2089x1764. Retinal fundus photograph.
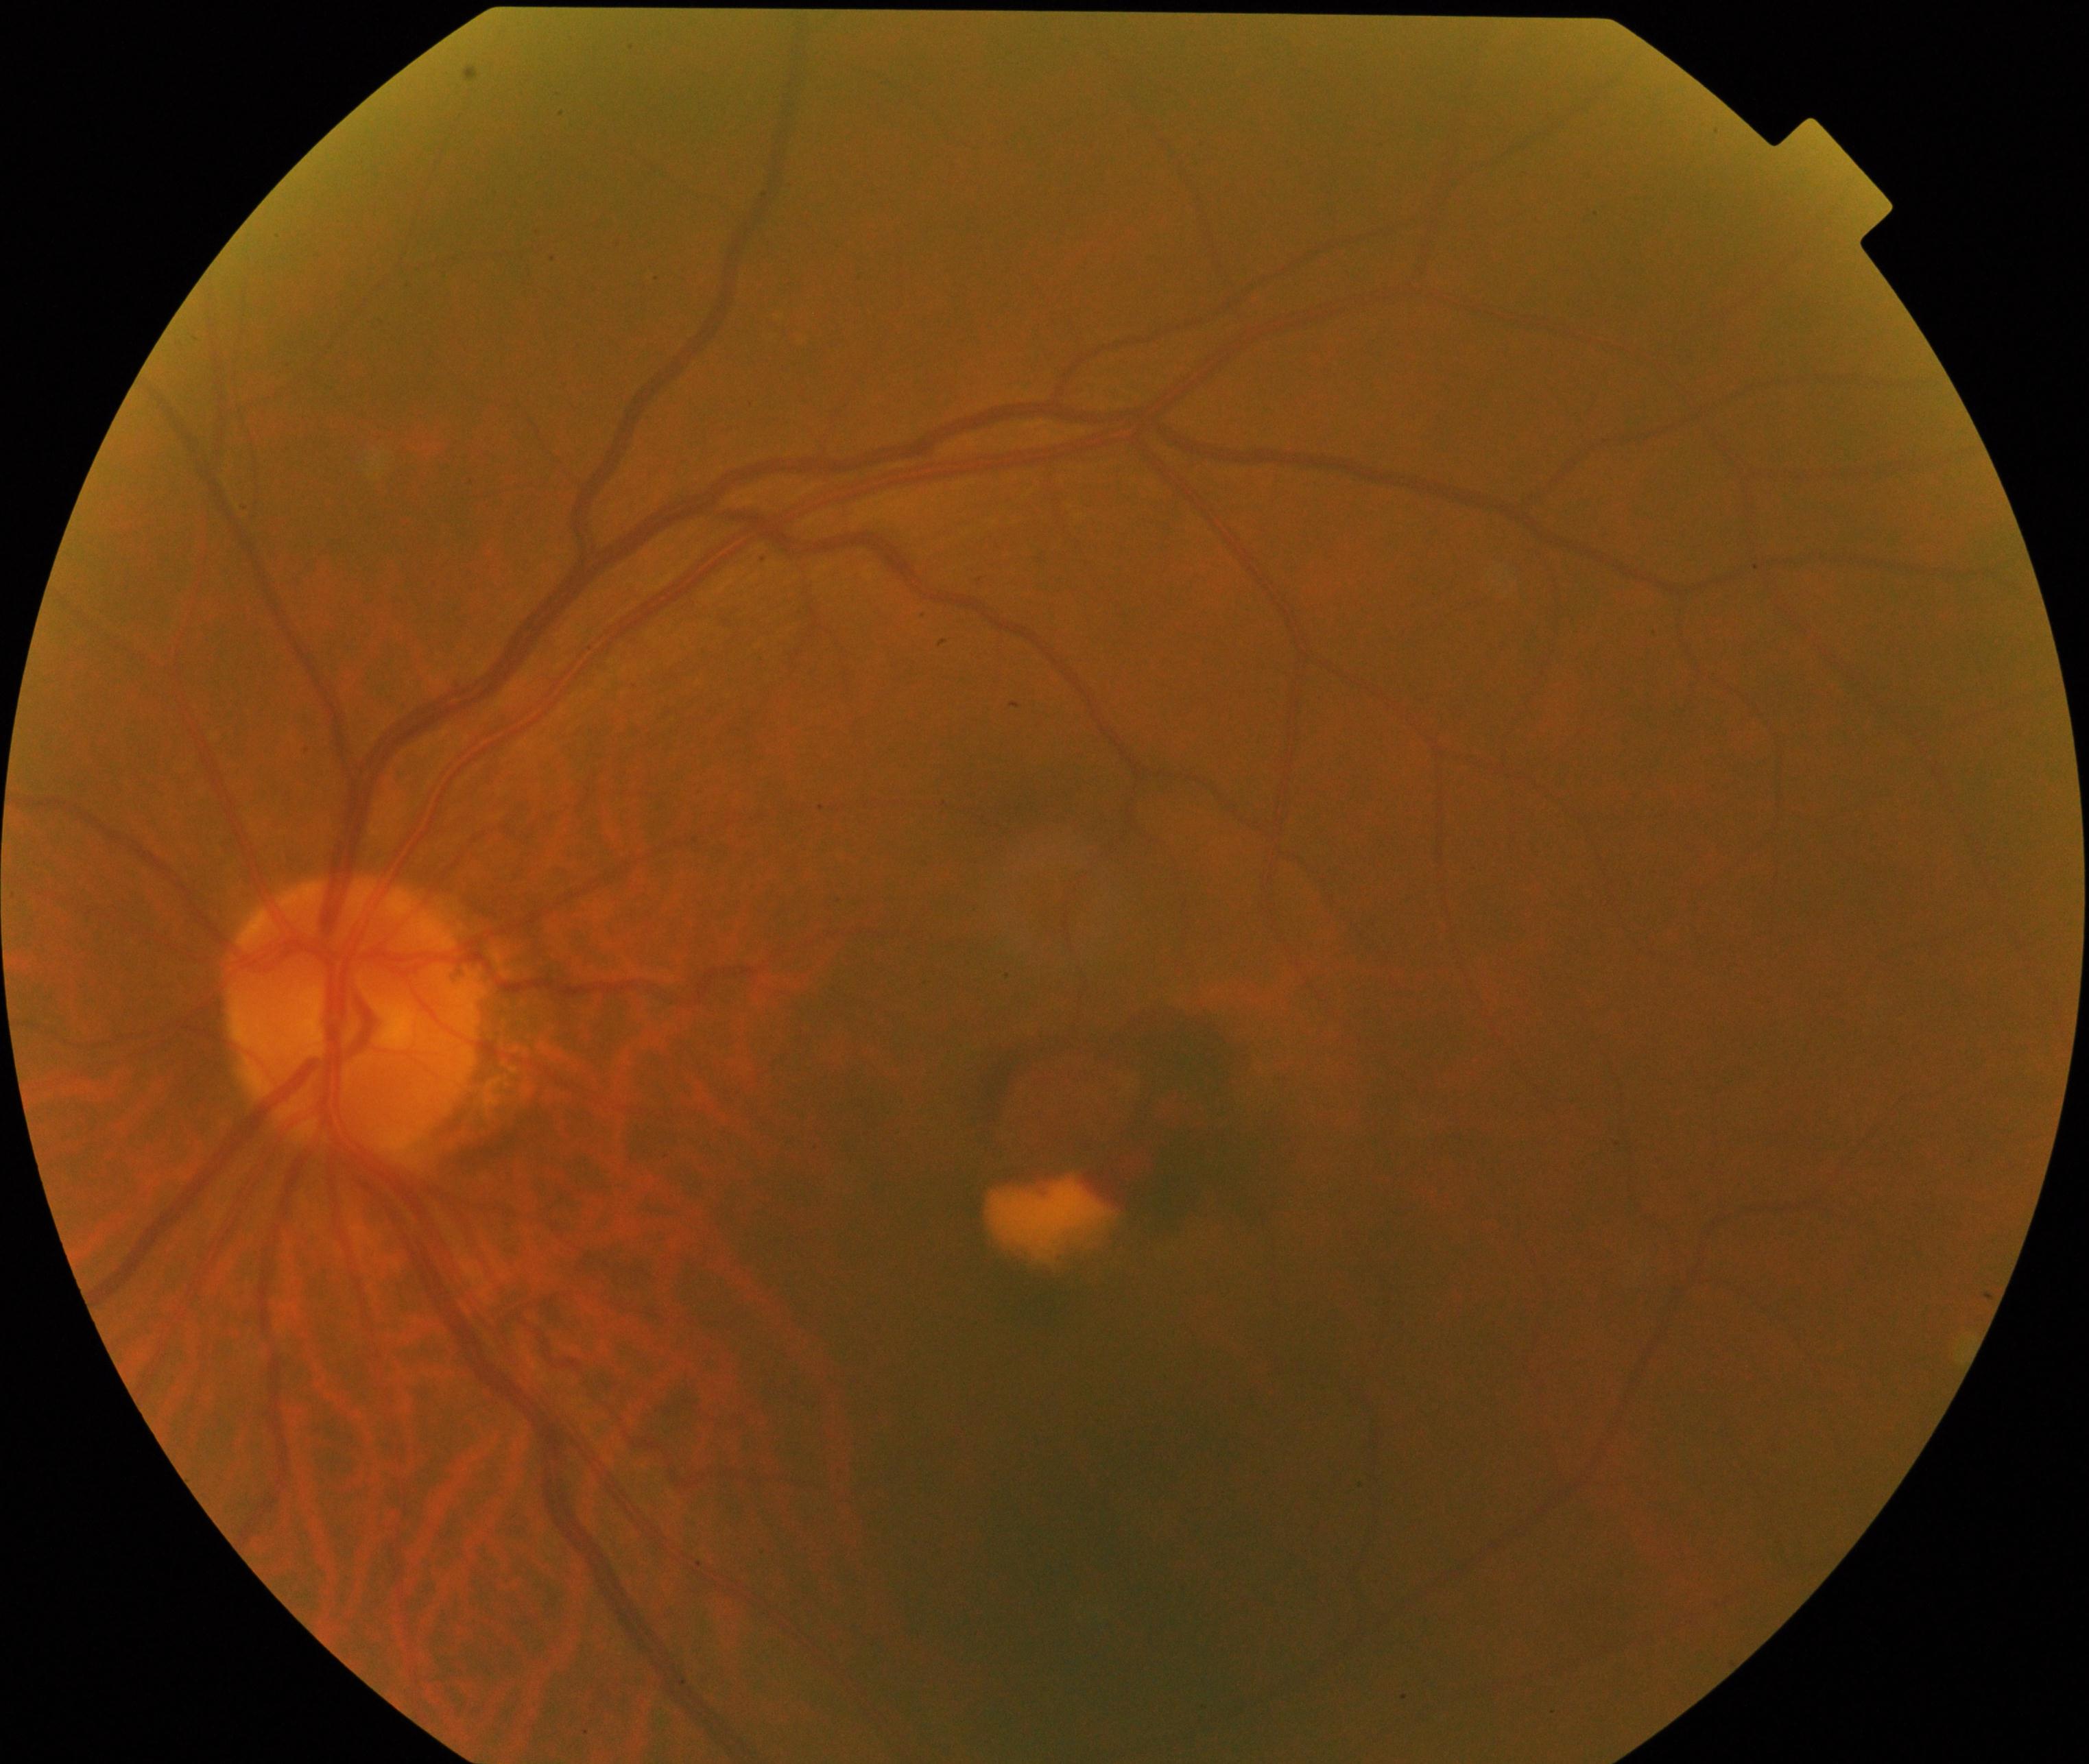 Appearance consistent with maculopathy.